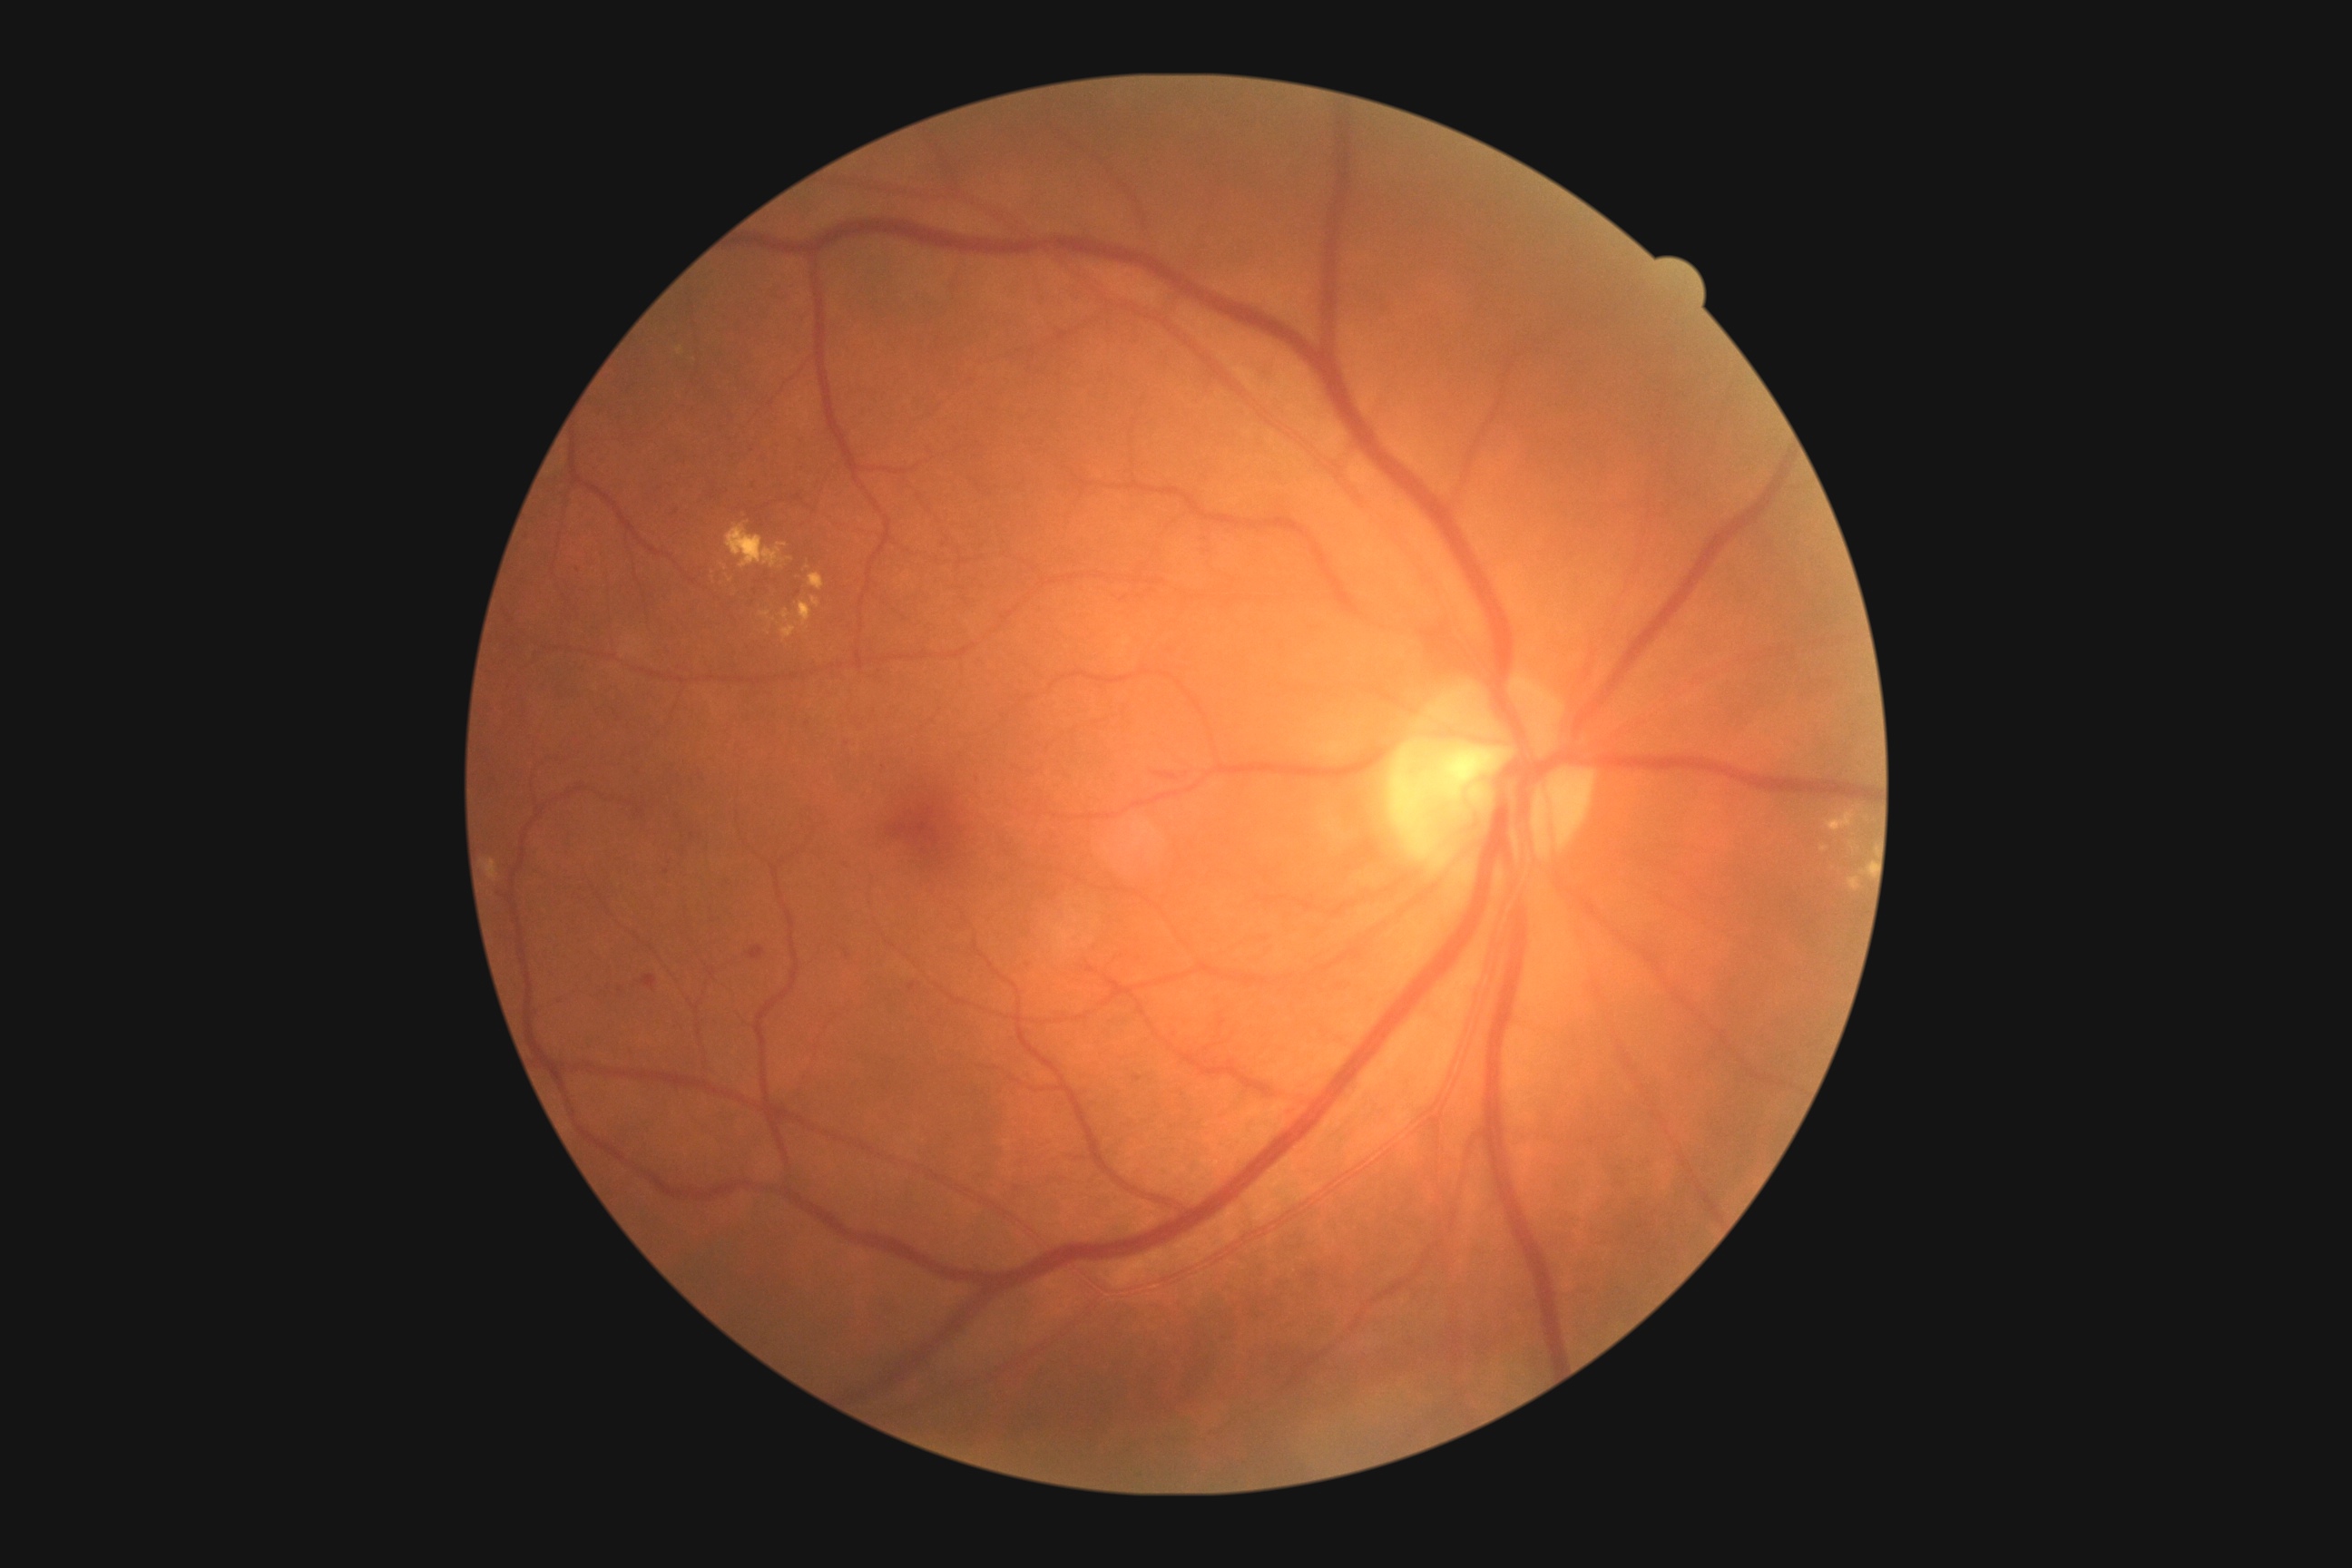
Diabetic retinopathy (DR) is grade 2 (moderate NPDR). The retinopathy is classified as non-proliferative diabetic retinopathy.